Image size 848x848. Acquired with a NIDEK AFC-230. Without pupil dilation.
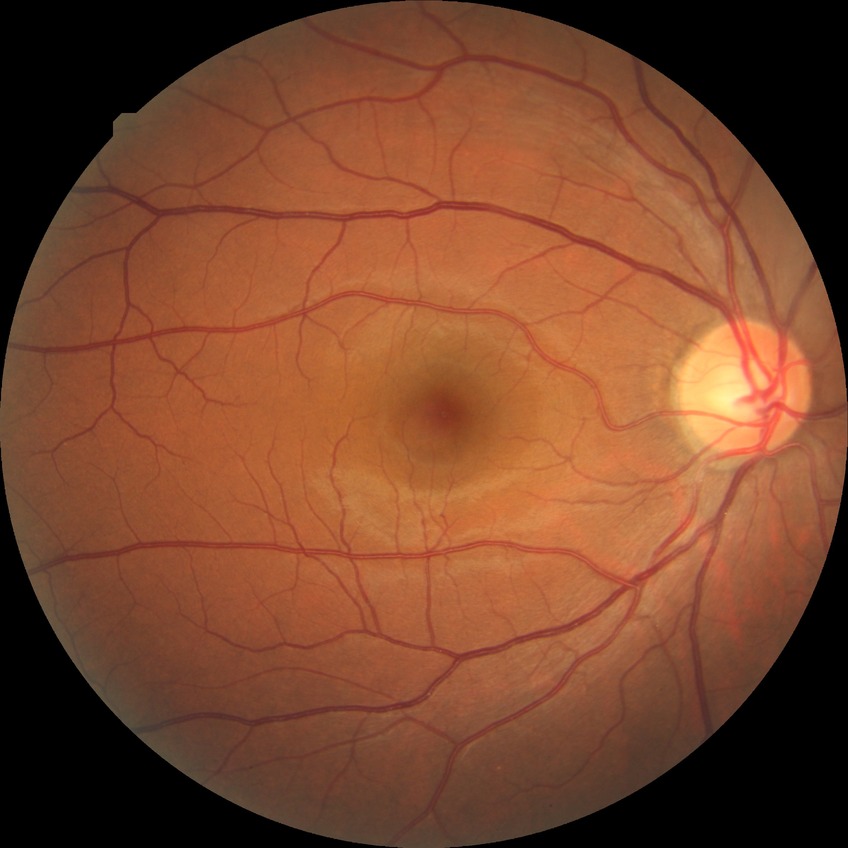

diabetic retinopathy (DR)=no diabetic retinopathy (NDR).